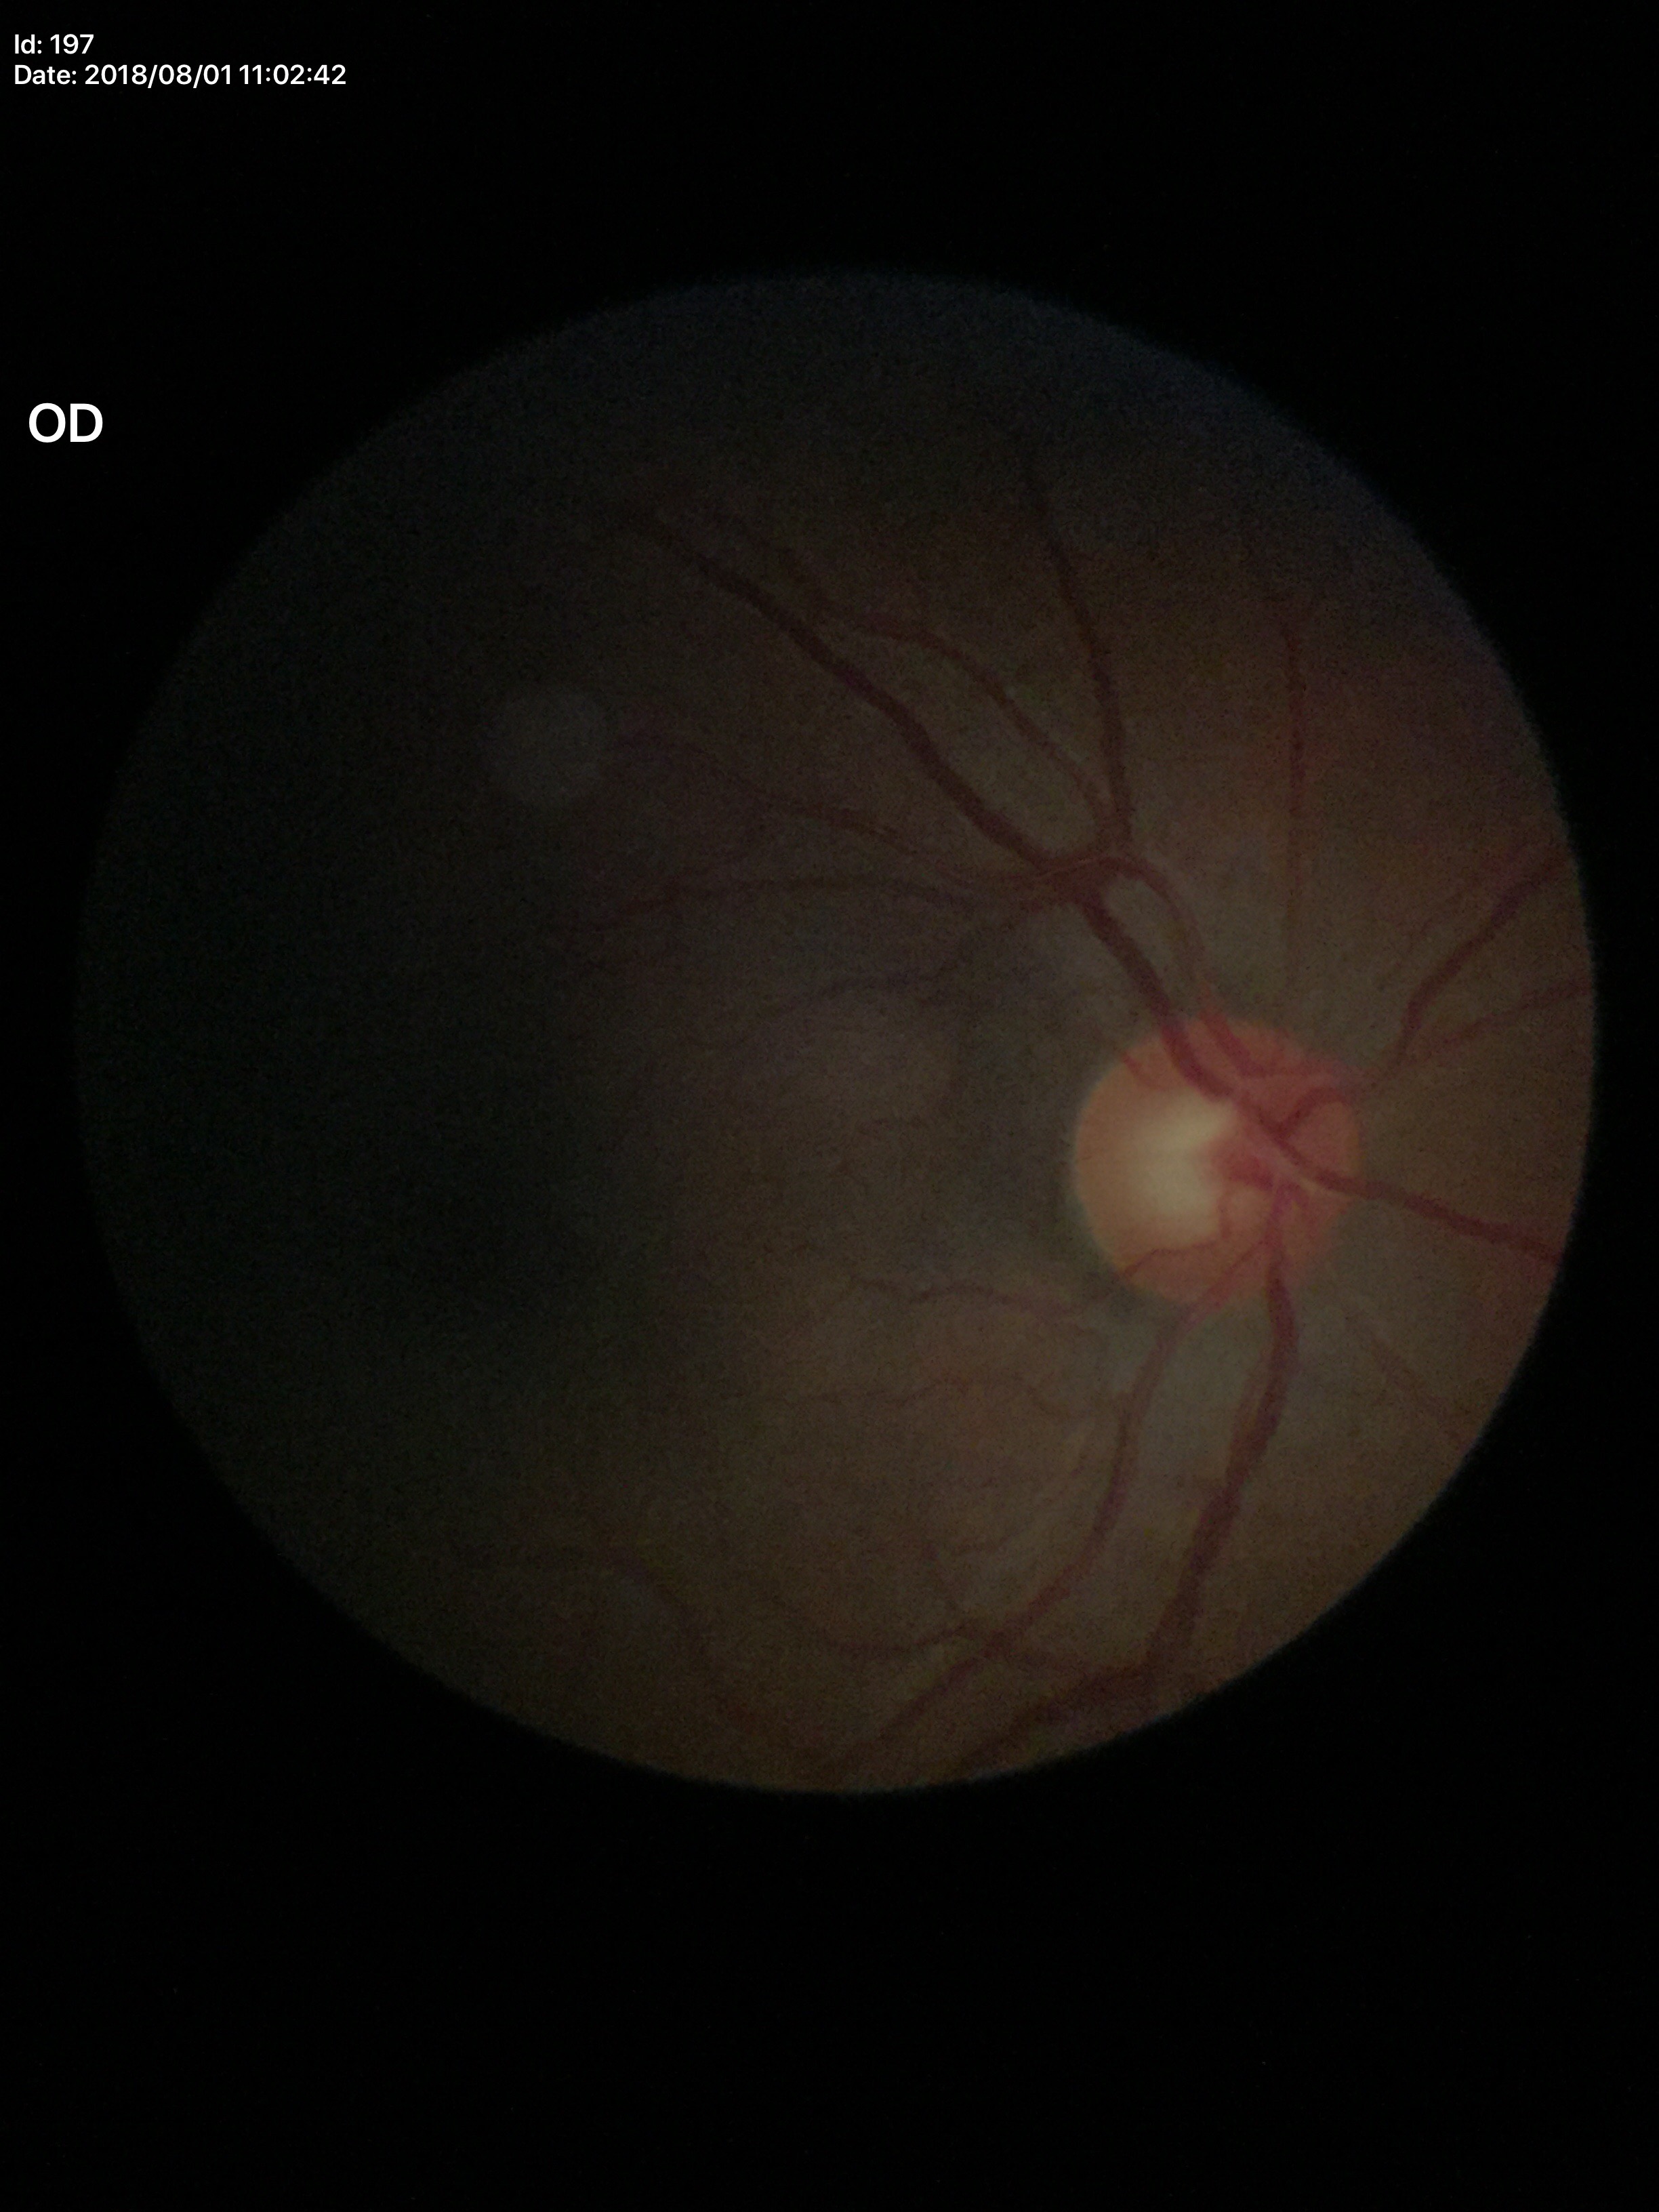
Optic disc analysis:
• Glaucoma decision · negative
• VCDR · 0.56
• HCDR · 0.60
• ACDR · 0.34